45-degree field of view; color fundus image; 2184 by 1690 pixels:
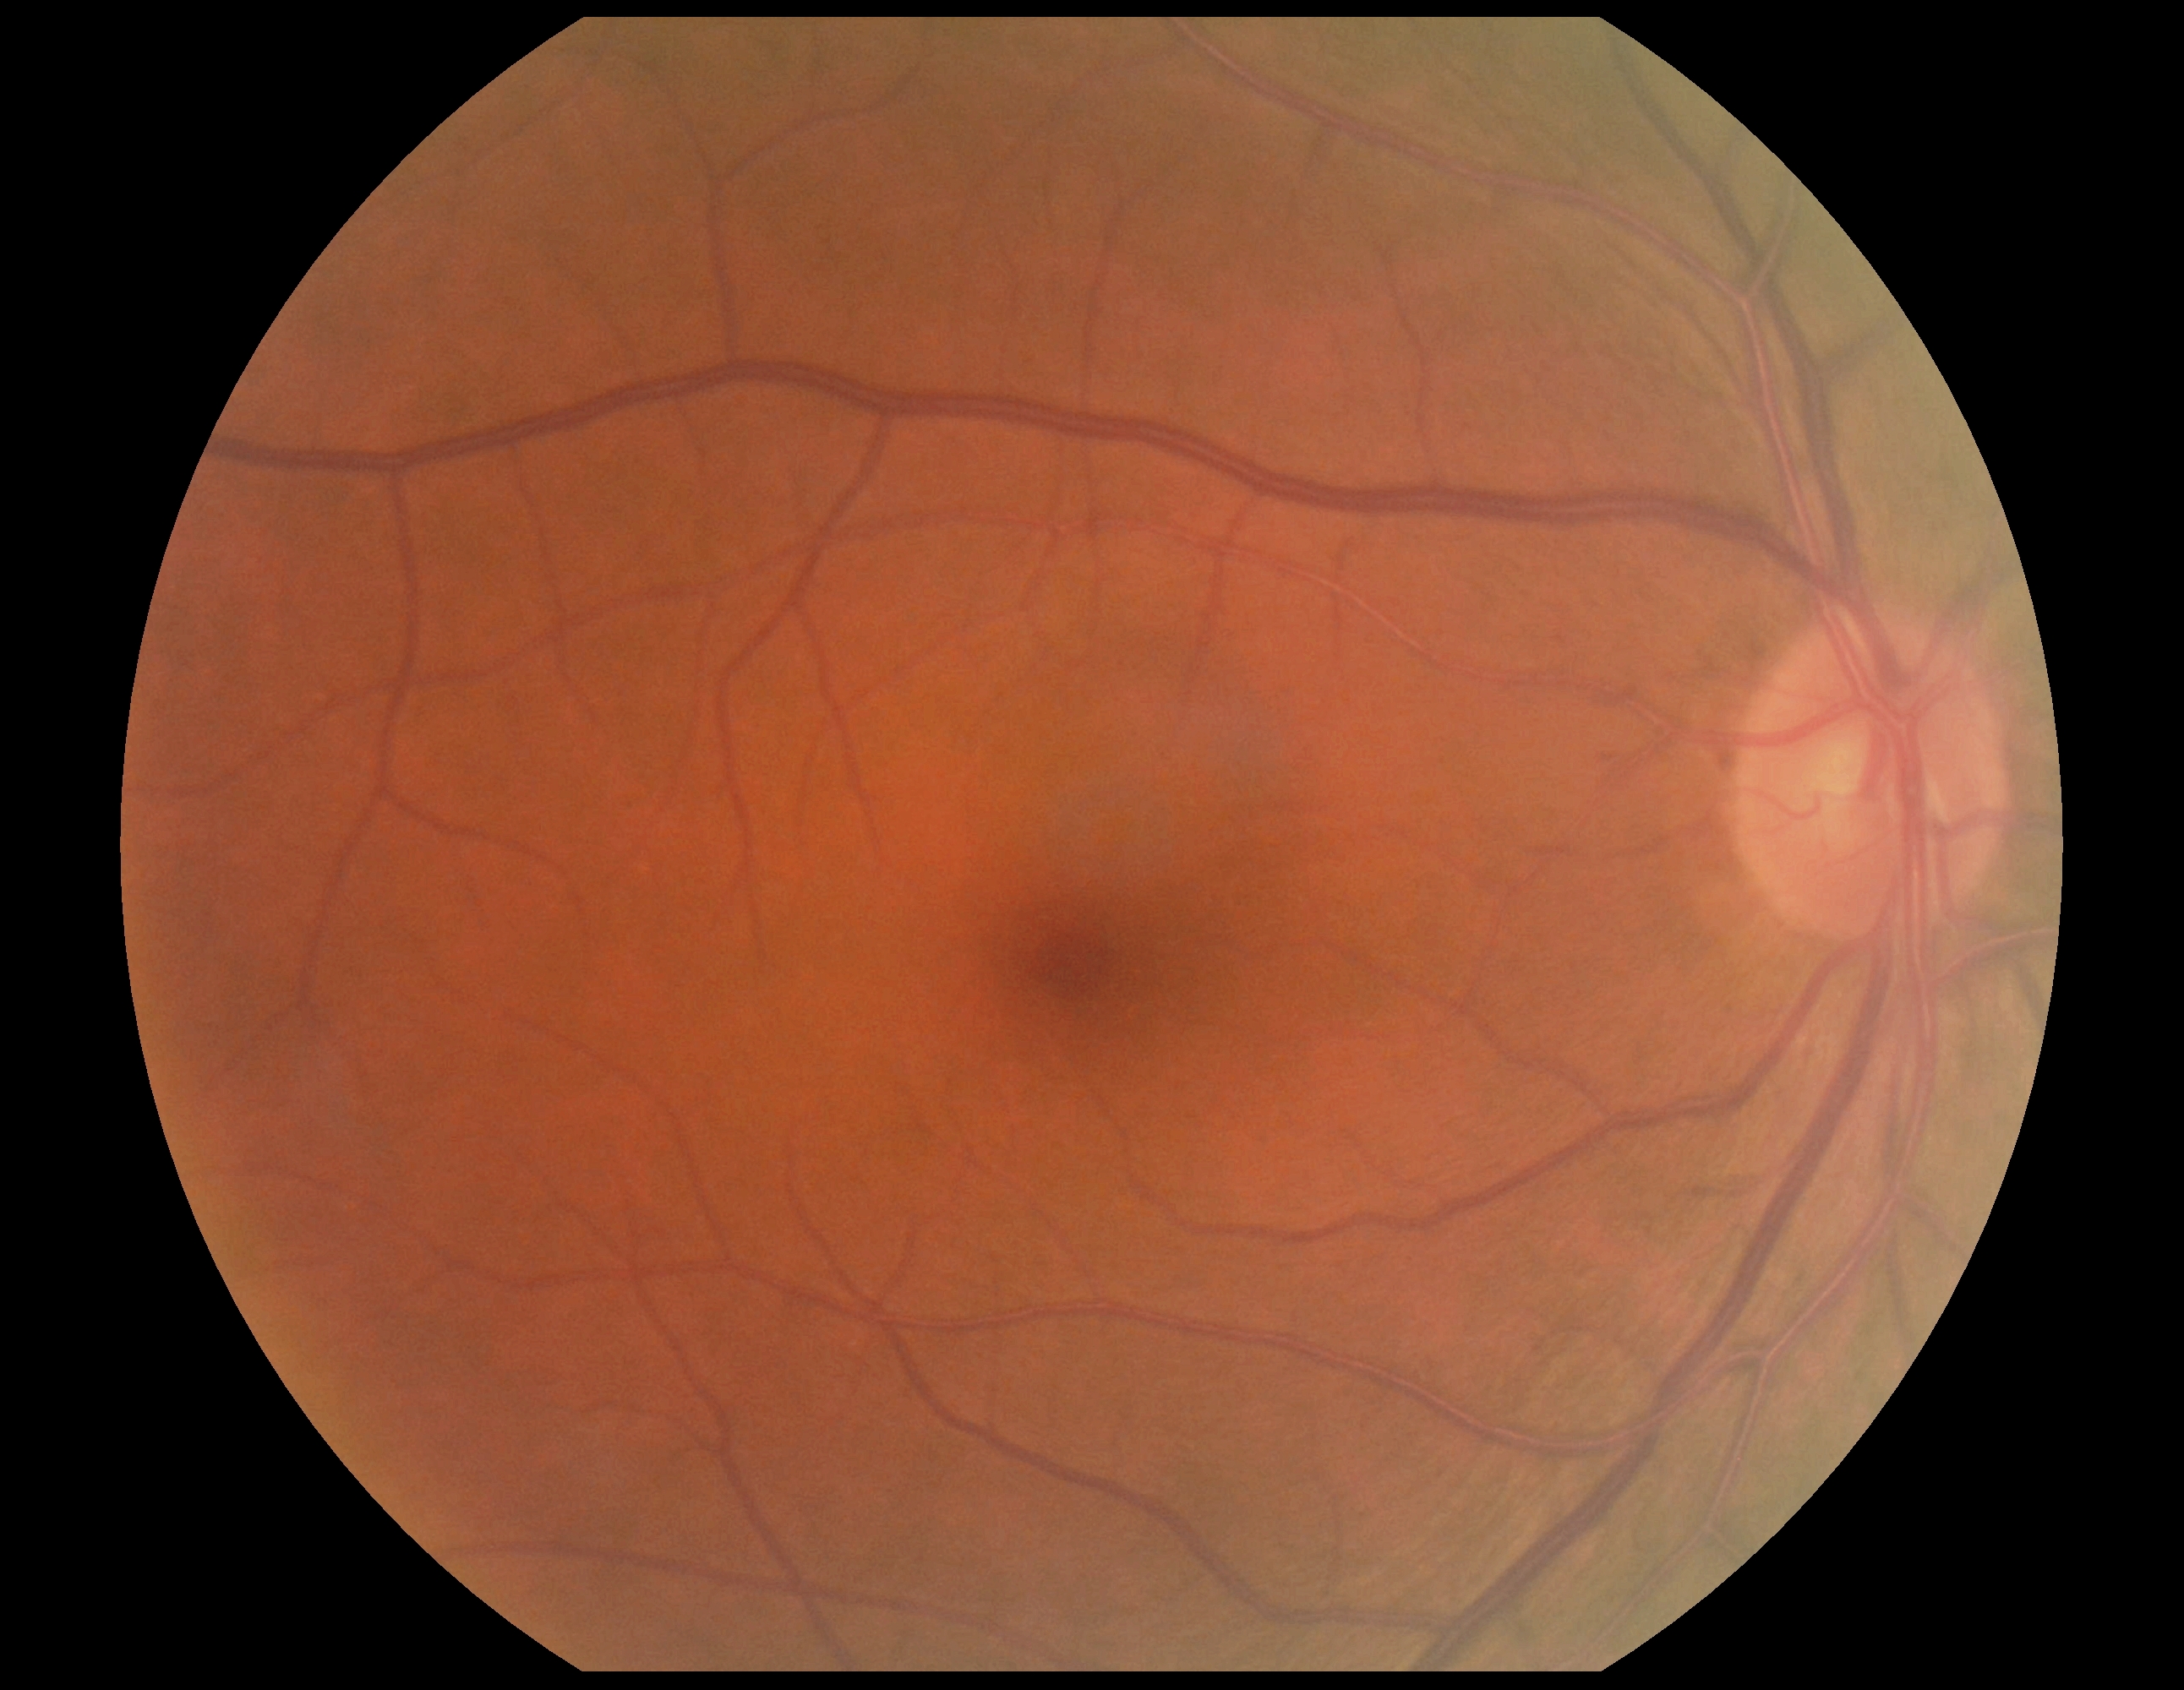
DR severity: grade 0 (no apparent retinopathy).